45 degree fundus photograph. 848x848px.
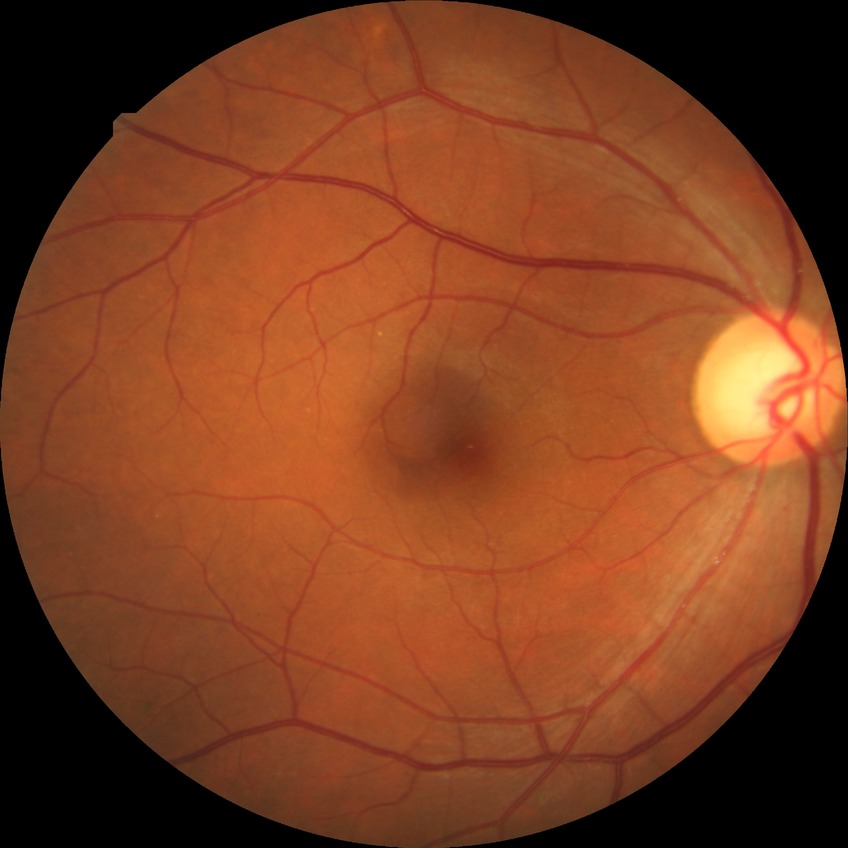 Annotations:
* diabetic retinopathy (DR): NDR (no diabetic retinopathy)